Portable fundus camera image: 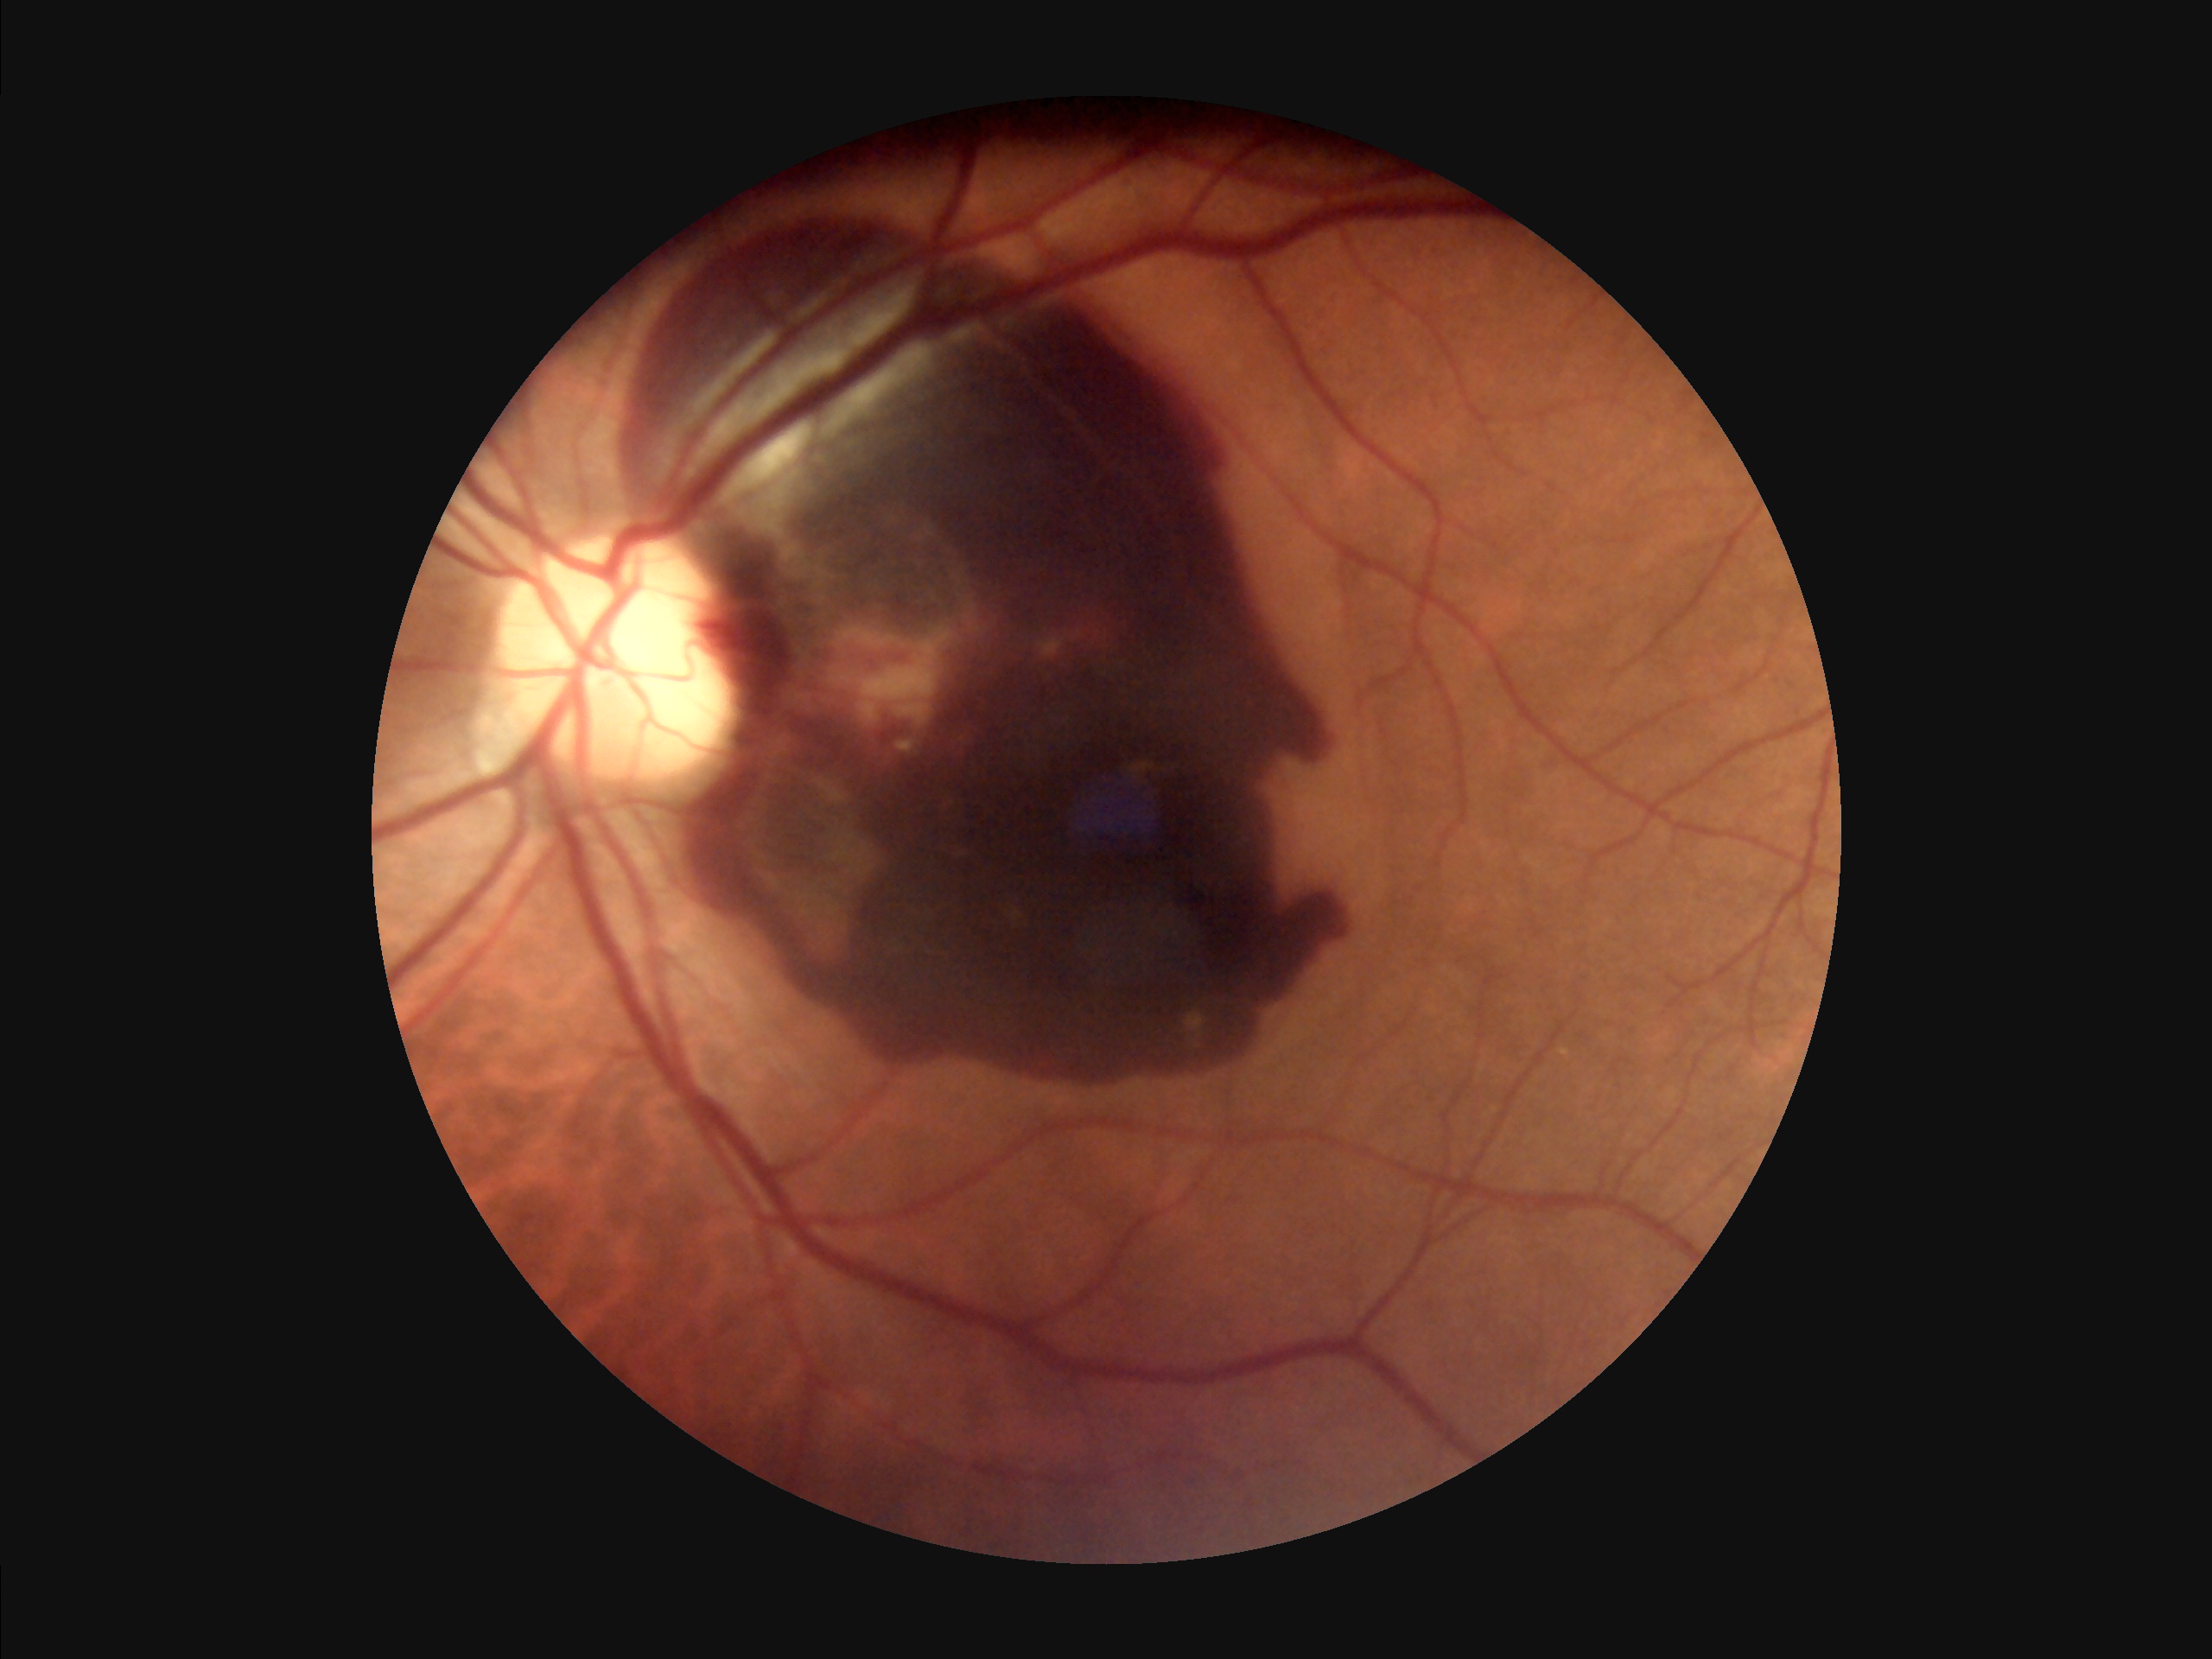
Contrast: vessels and details readily distinguishable; Illumination/color: no over- or under-exposure; Focus: sharp throughout the field; Overall image quality: good, gradable.